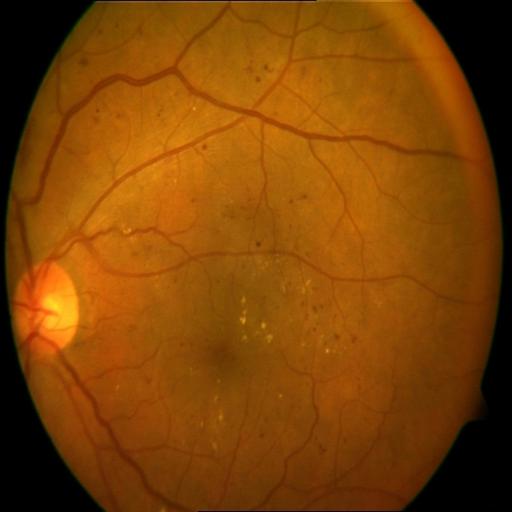
Demonstrates hemorrhagic retinopathy and exudation.